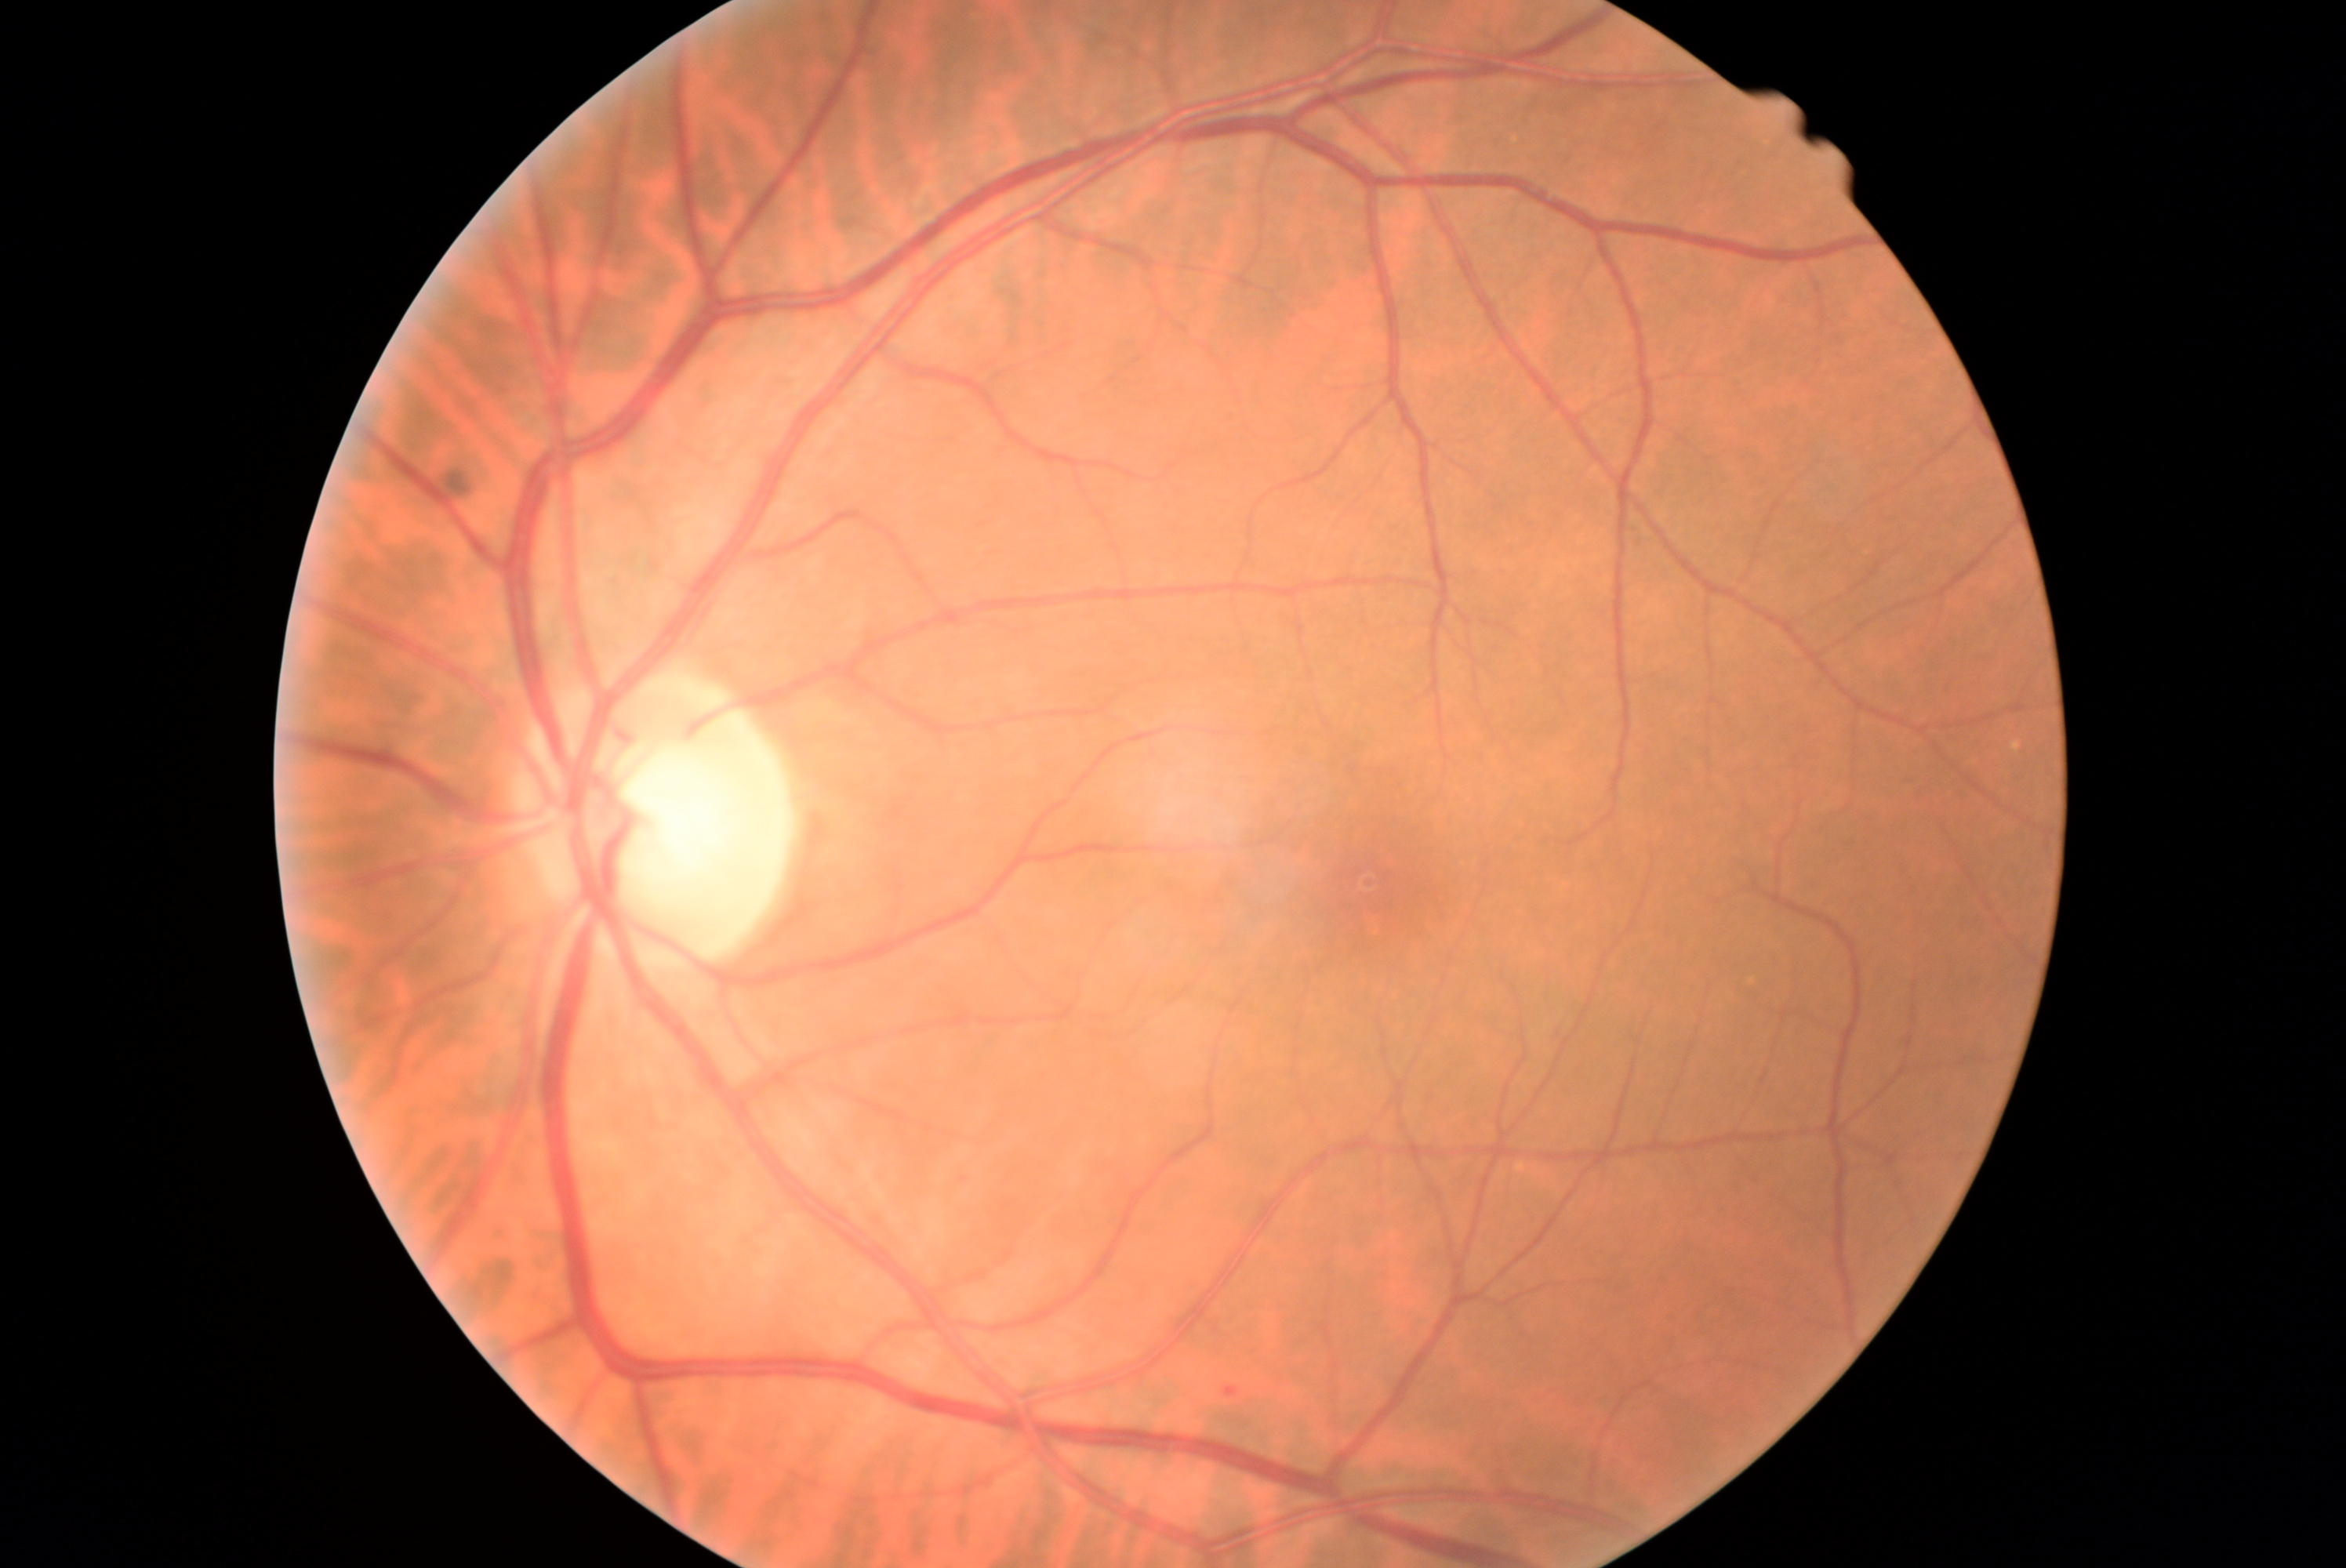

Diabetic retinopathy (DR): grade 1 (mild NPDR).